Retinal fundus photograph — 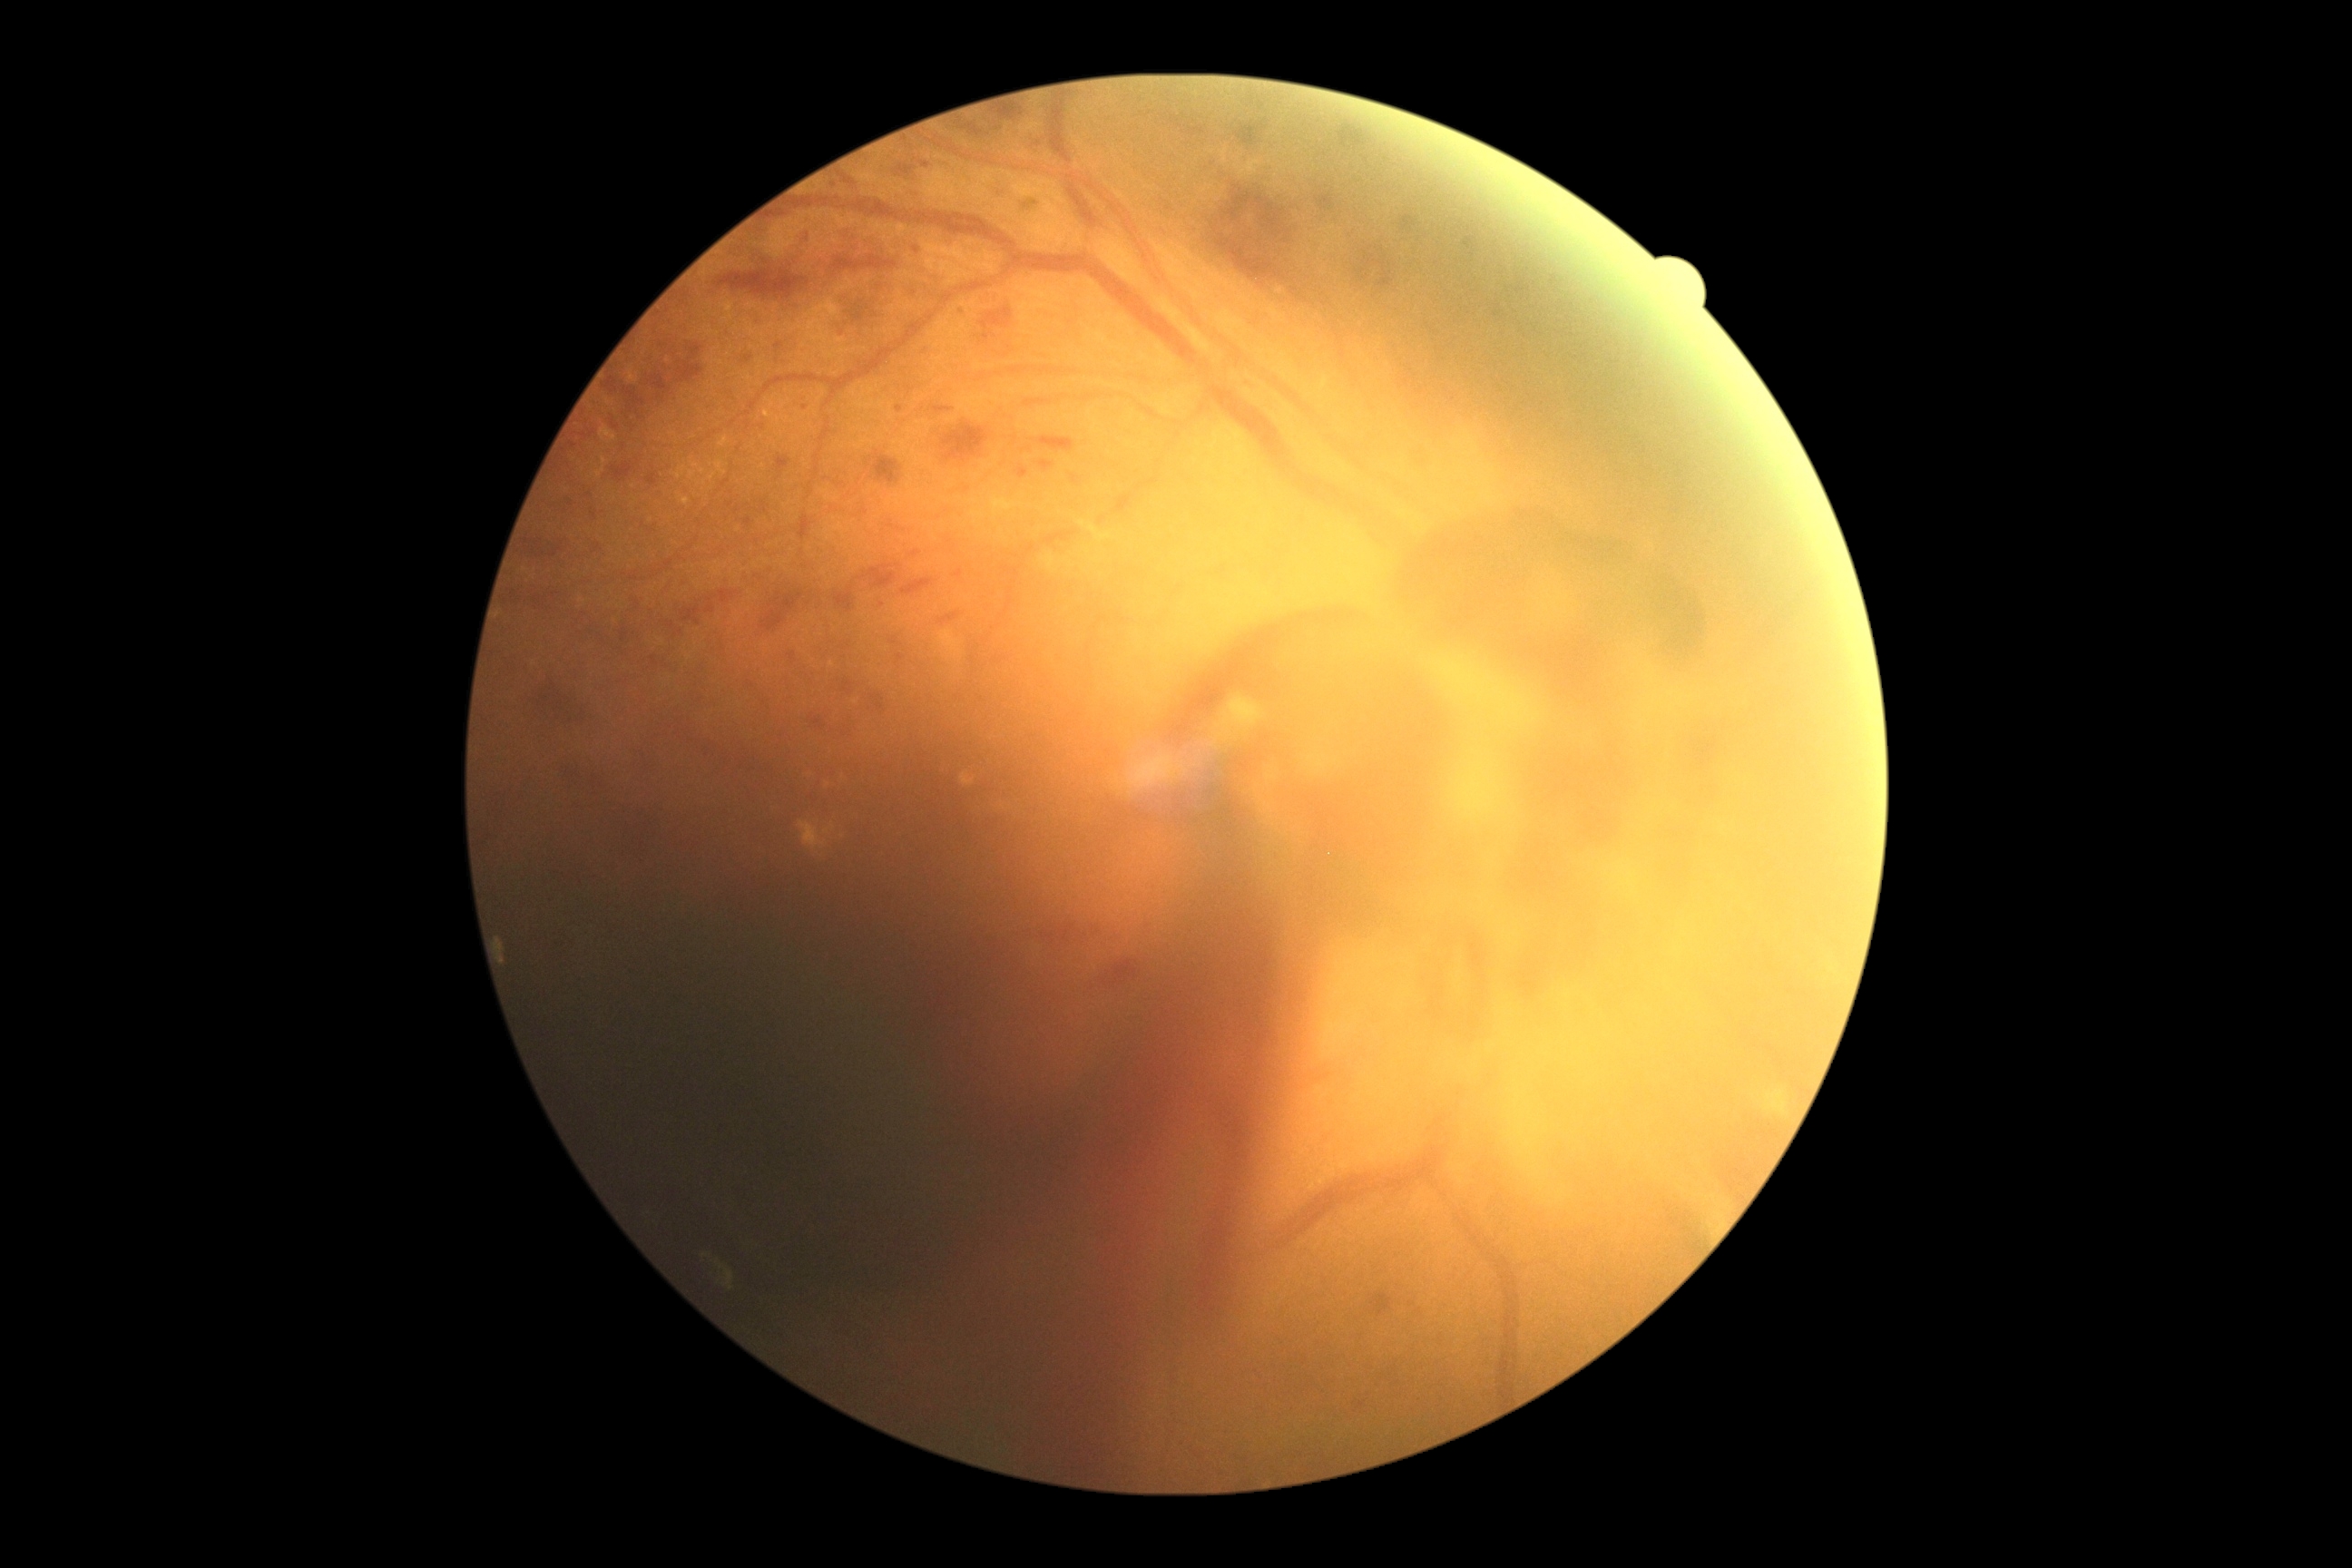
diabetic retinopathy (DR) = grade 4